CFP, FOV: 45 degrees, image size 2212x1659.
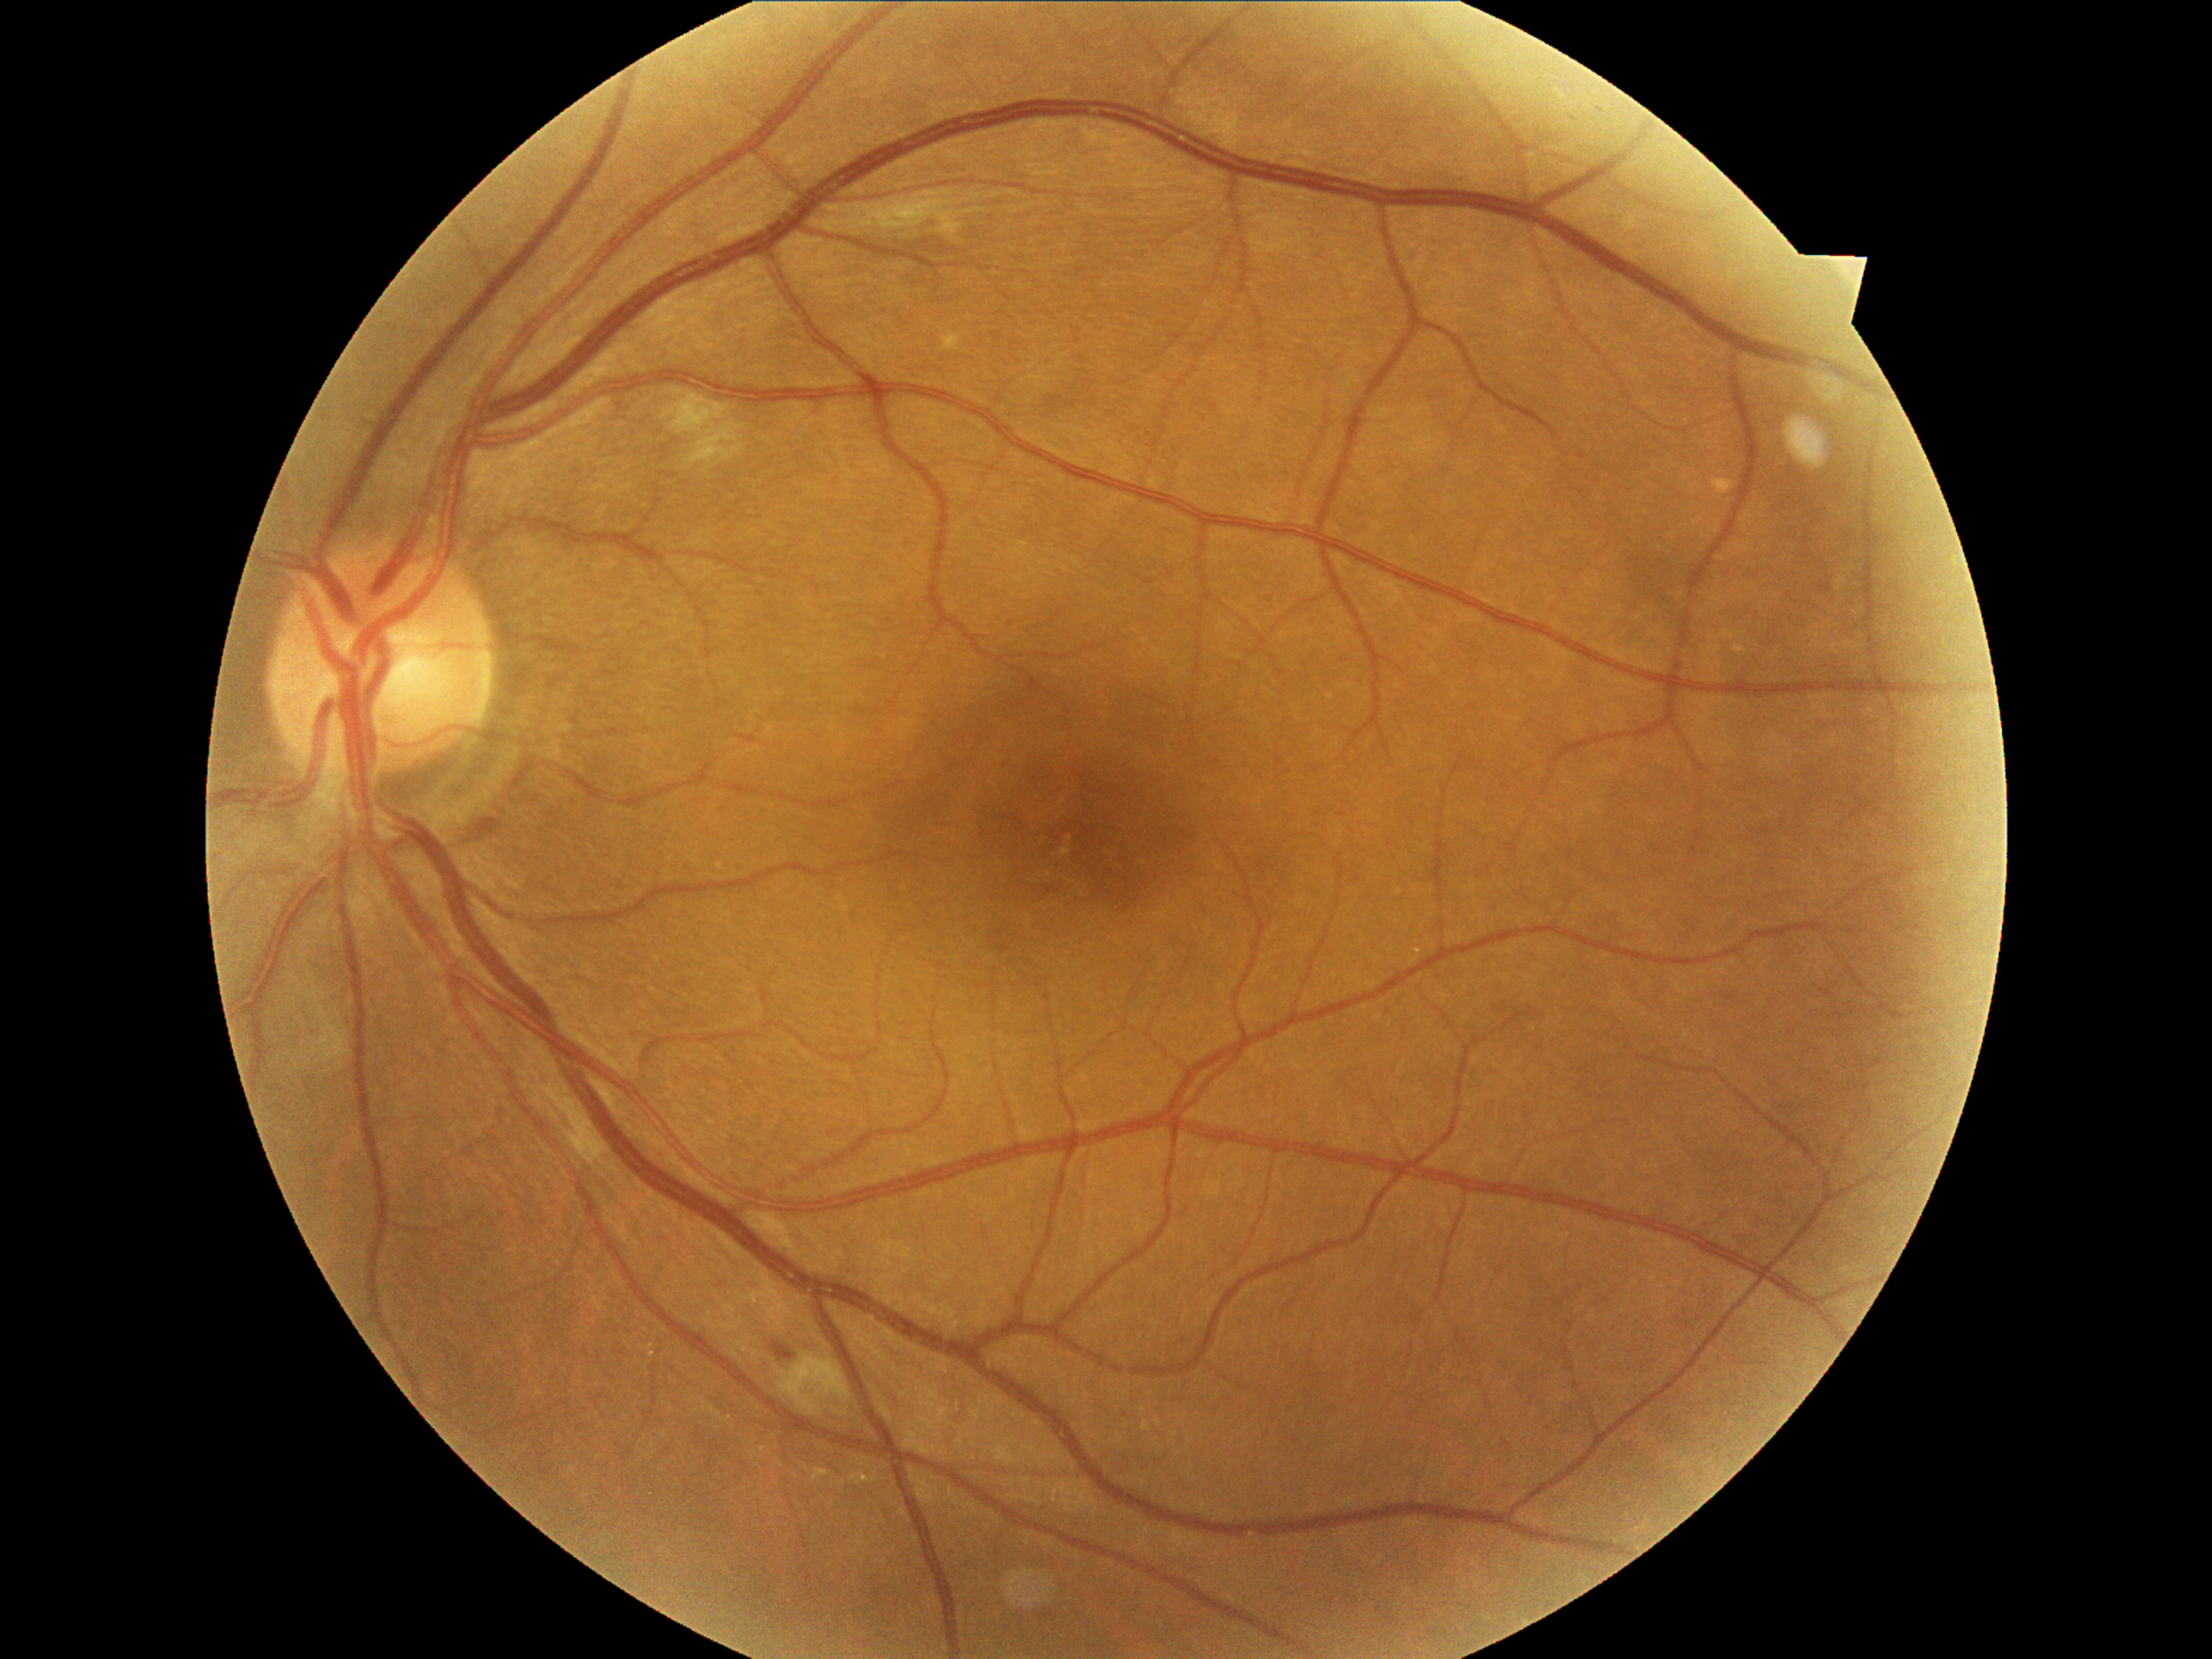

Diabetic retinopathy grade: 2 (moderate NPDR).